Fundus photo: 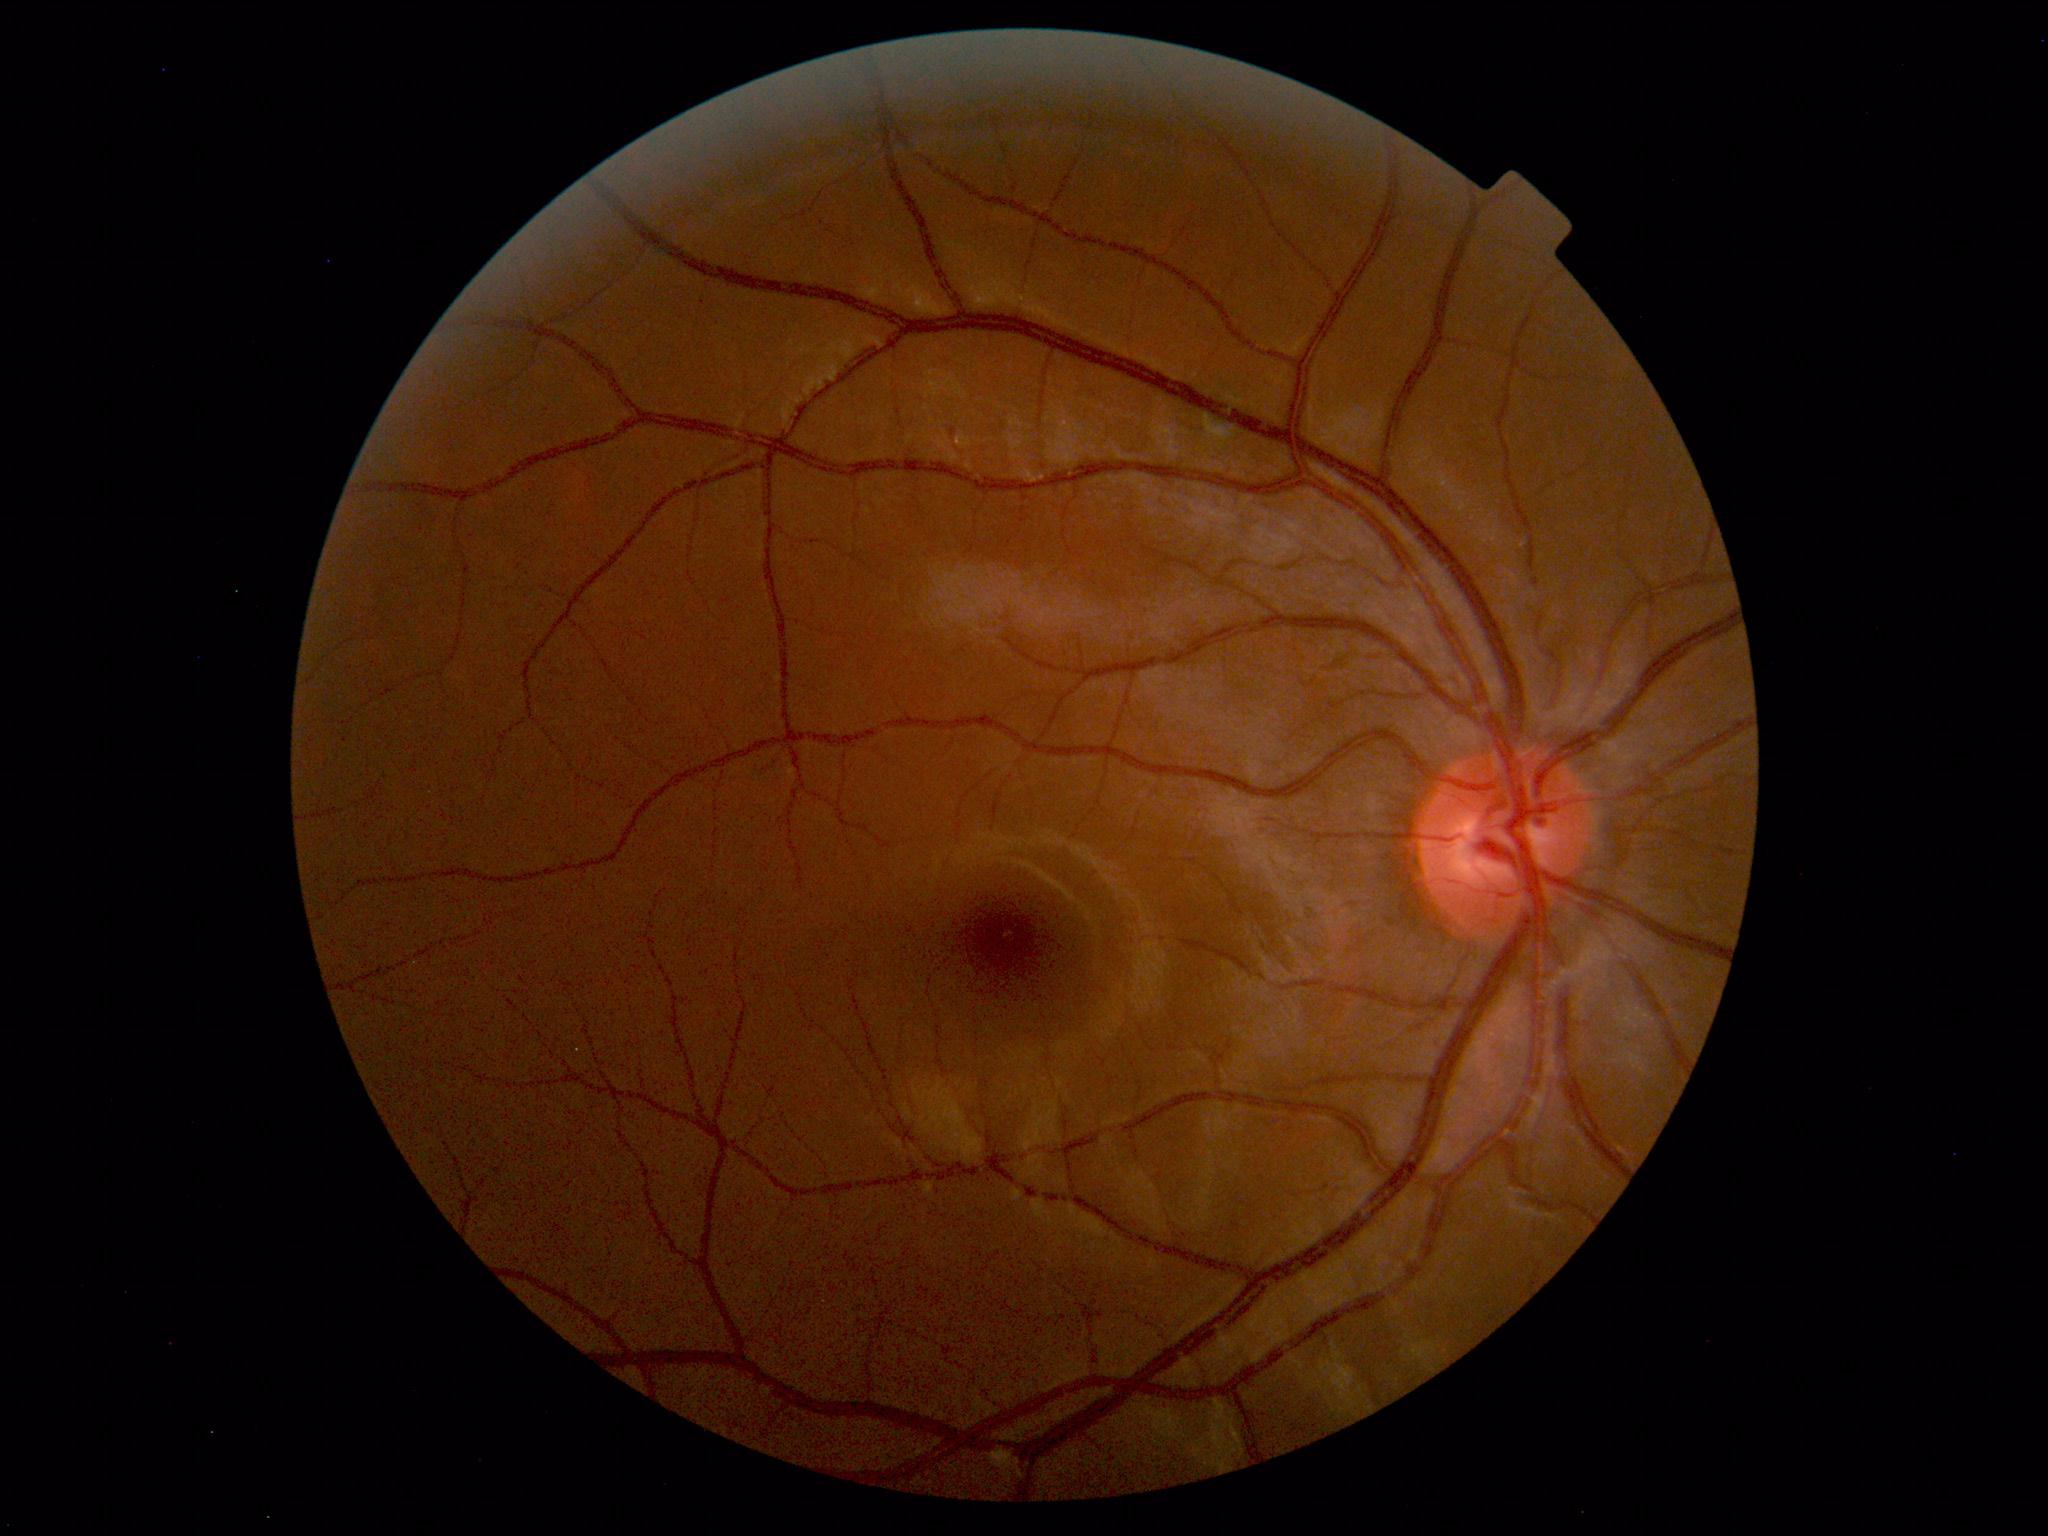 Findings: no abnormalities.